No pharmacologic dilation, NIDEK AFC-230:
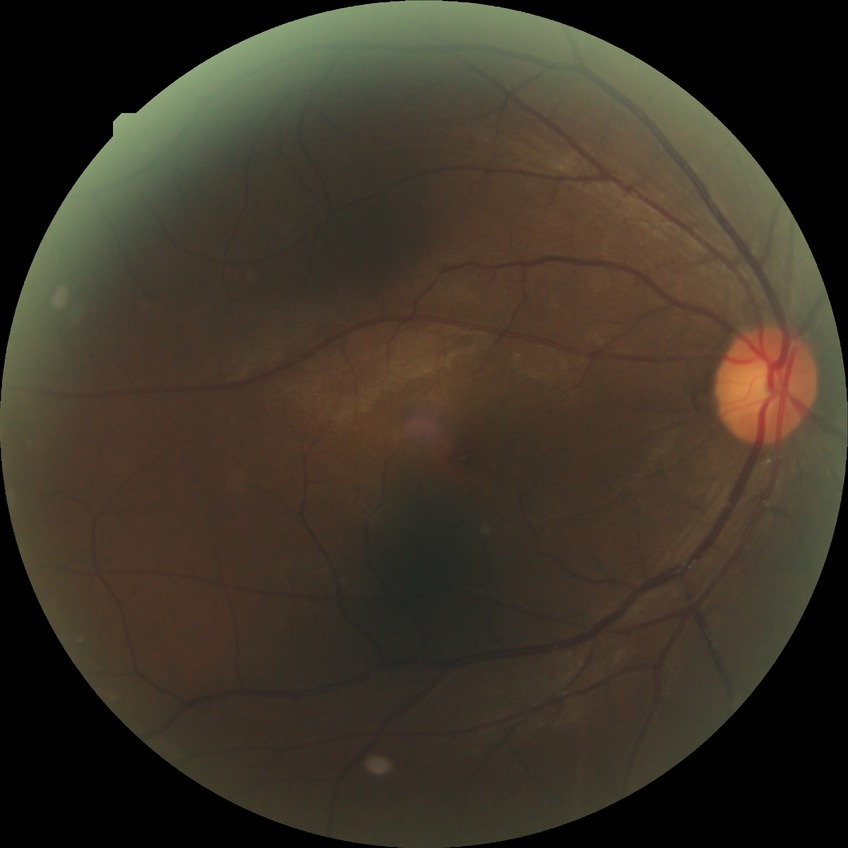 davis_grade: SDR